No pharmacologic dilation · retinal fundus photograph · NIDEK AFC-230:
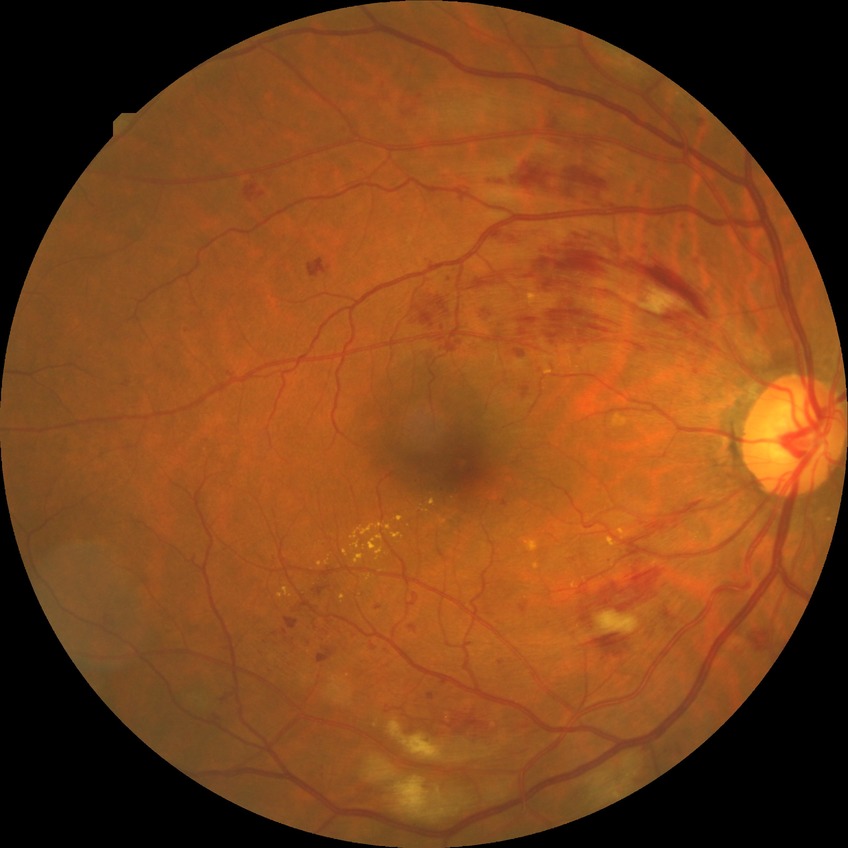
Disease class: non-proliferative diabetic retinopathy. Diabetic retinopathy severity is pre-proliferative diabetic retinopathy.